Fundus photo.
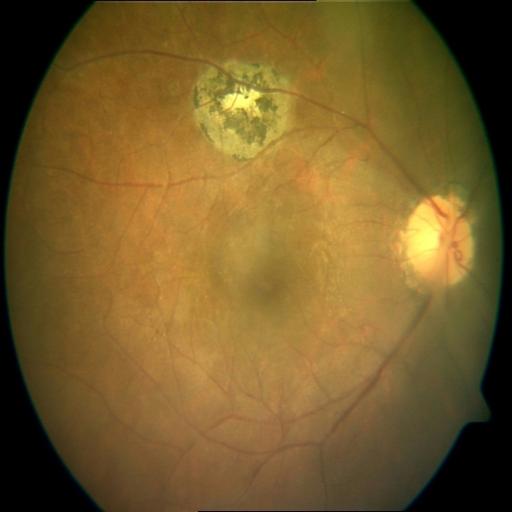
Diagnosis: MS (macular scar).